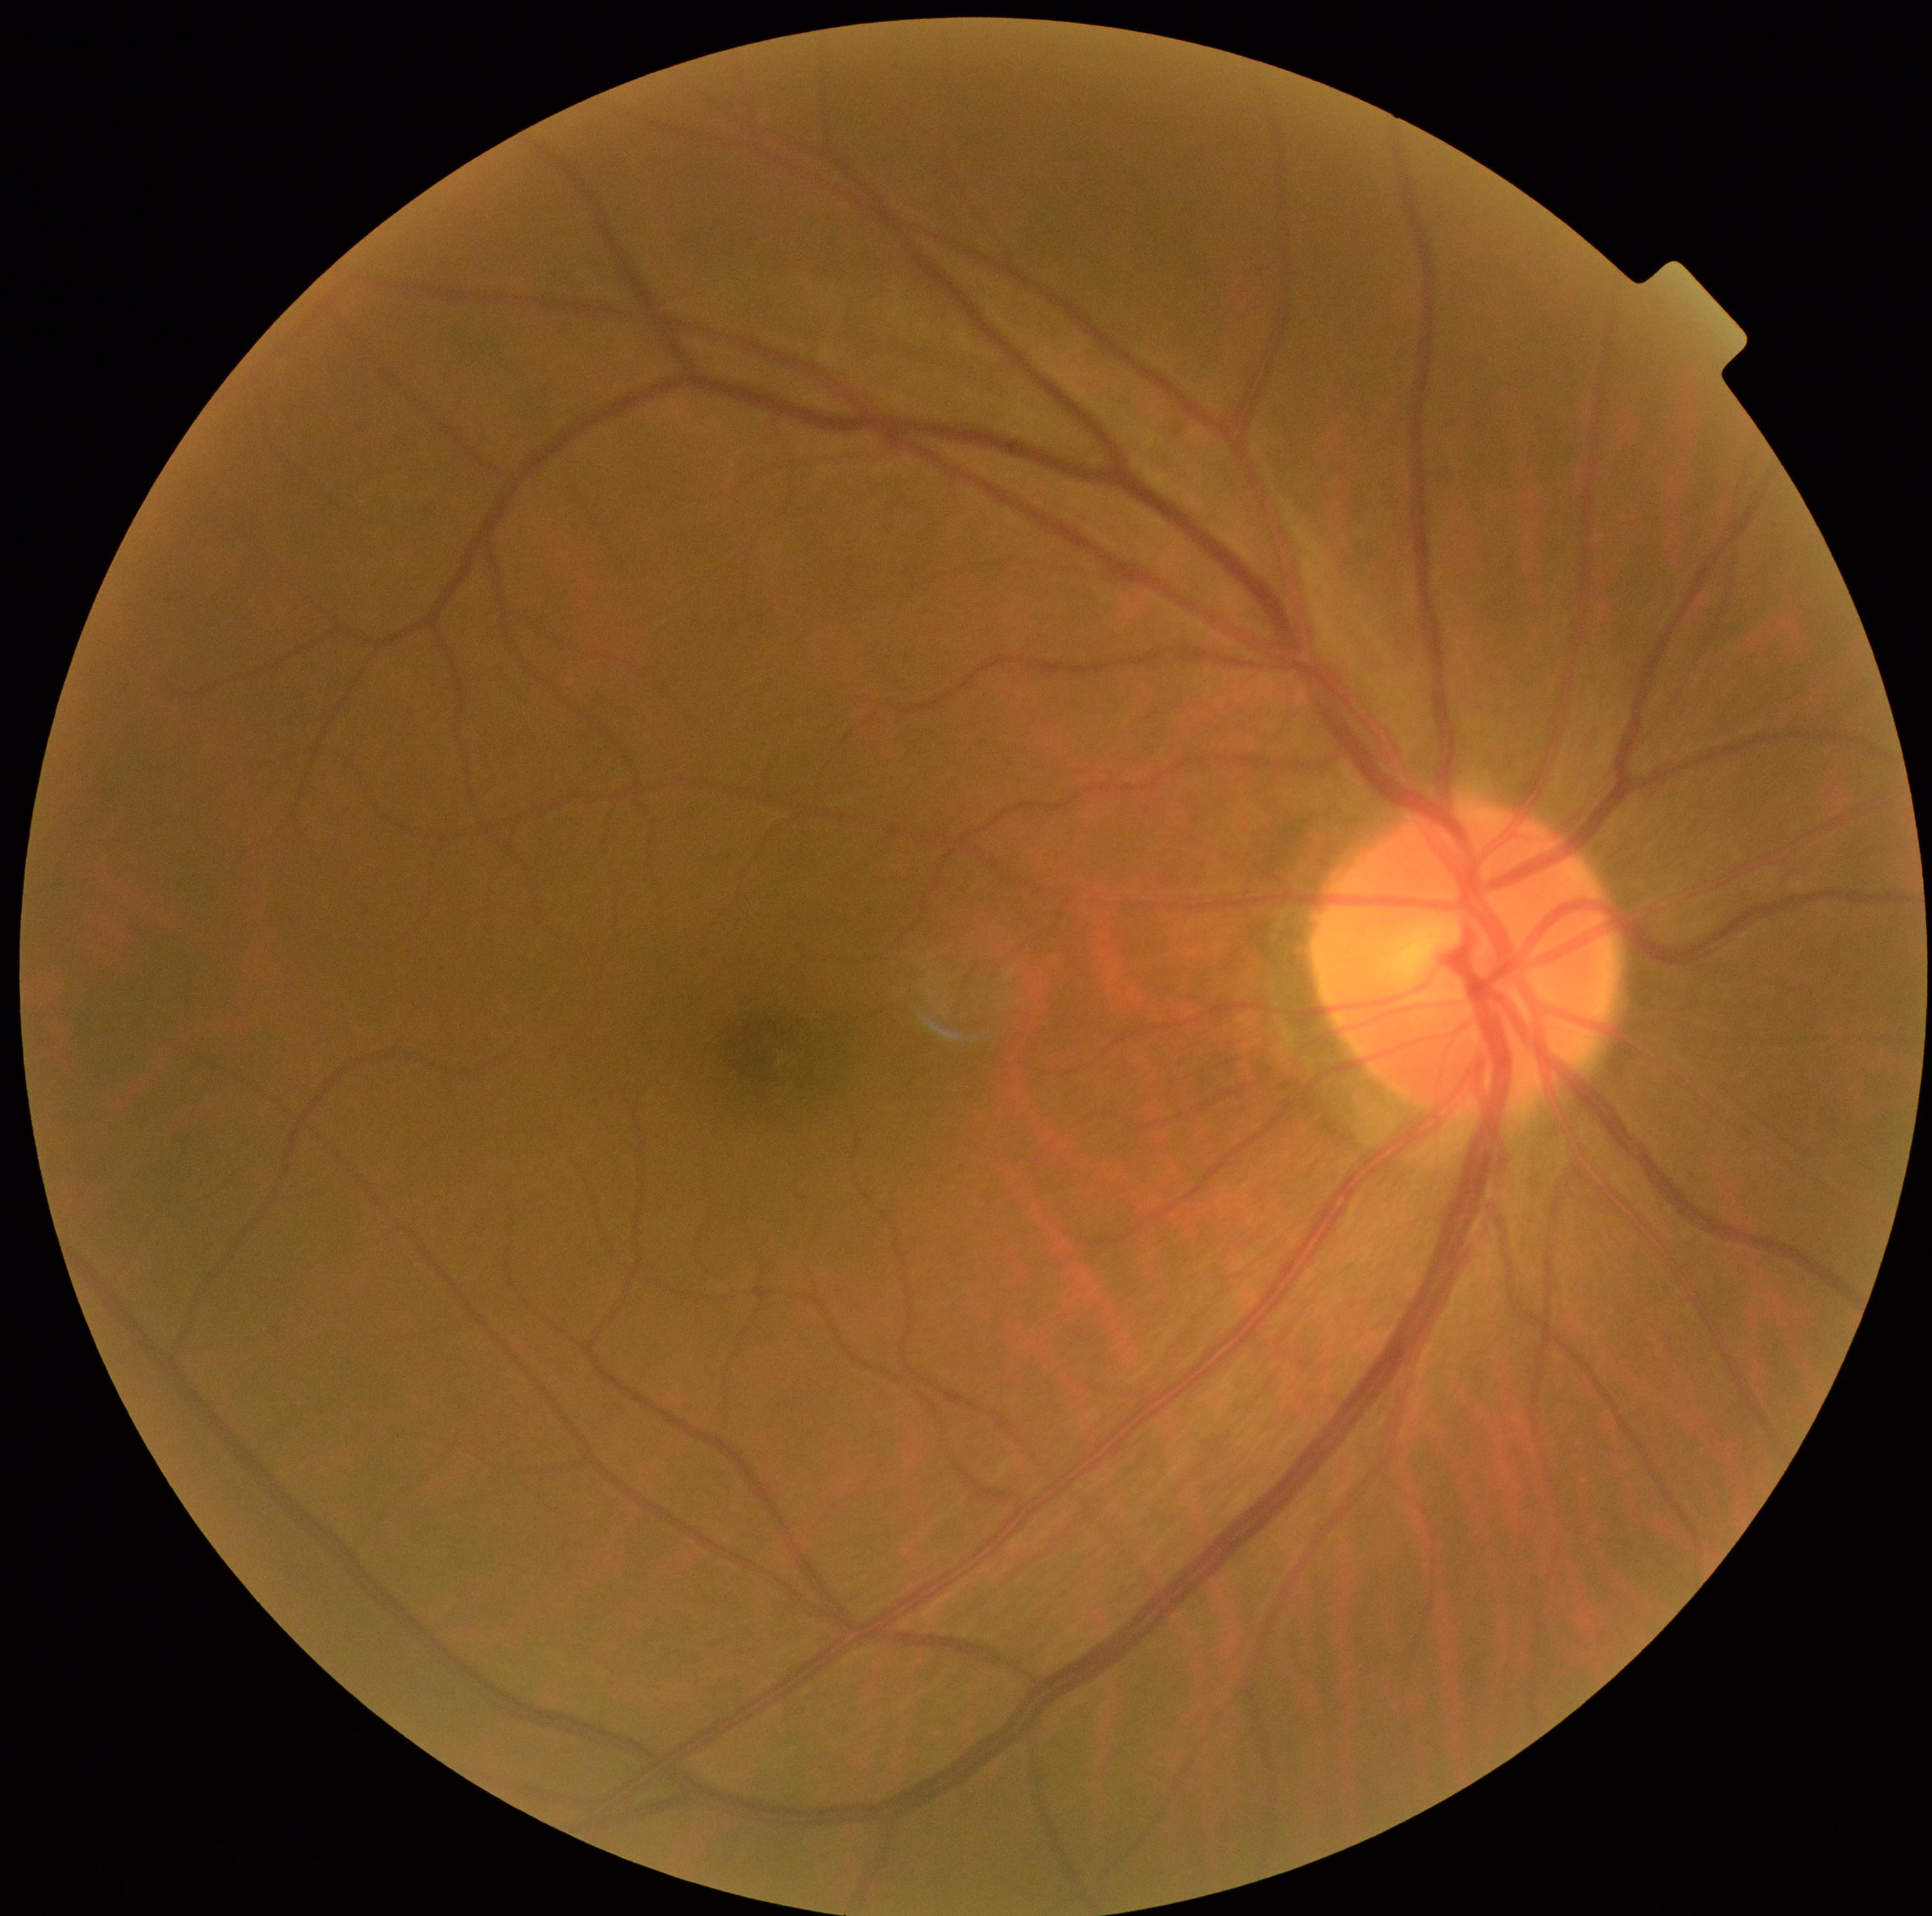

Diabetic retinopathy (DR): grade 0.